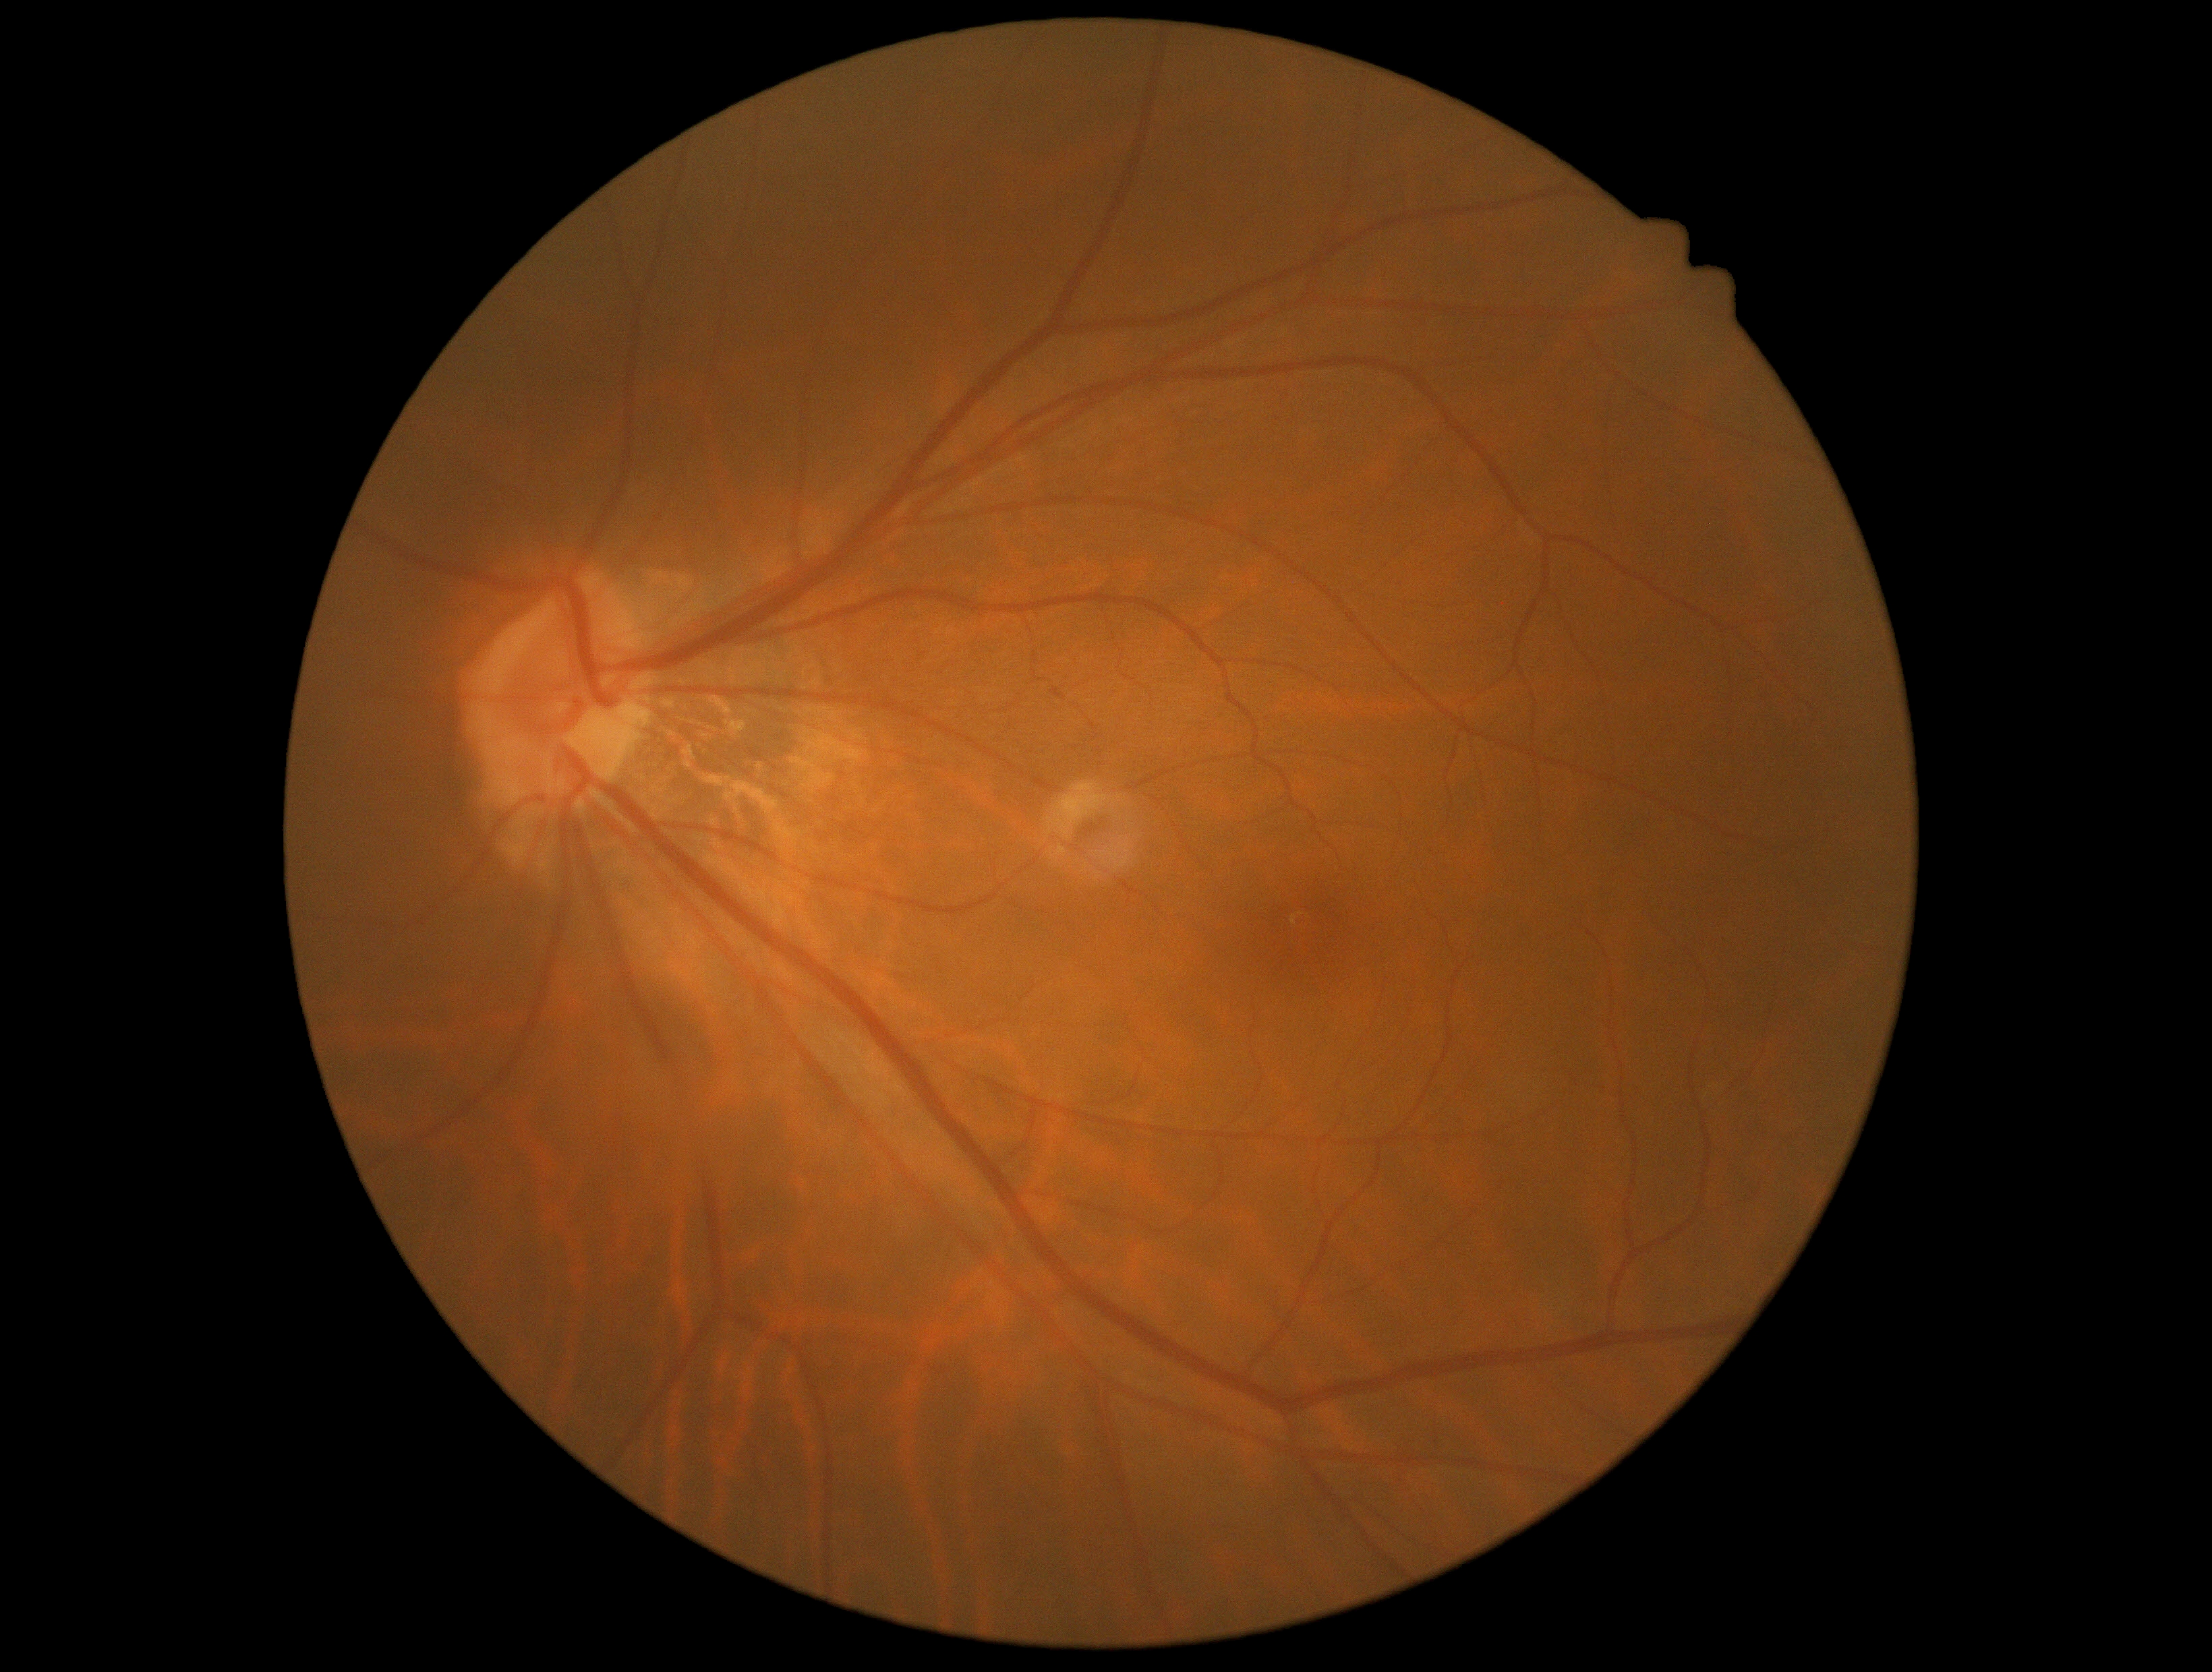 DR impression = no apparent DR
diabetic retinopathy (DR) = 0